Color fundus photograph — 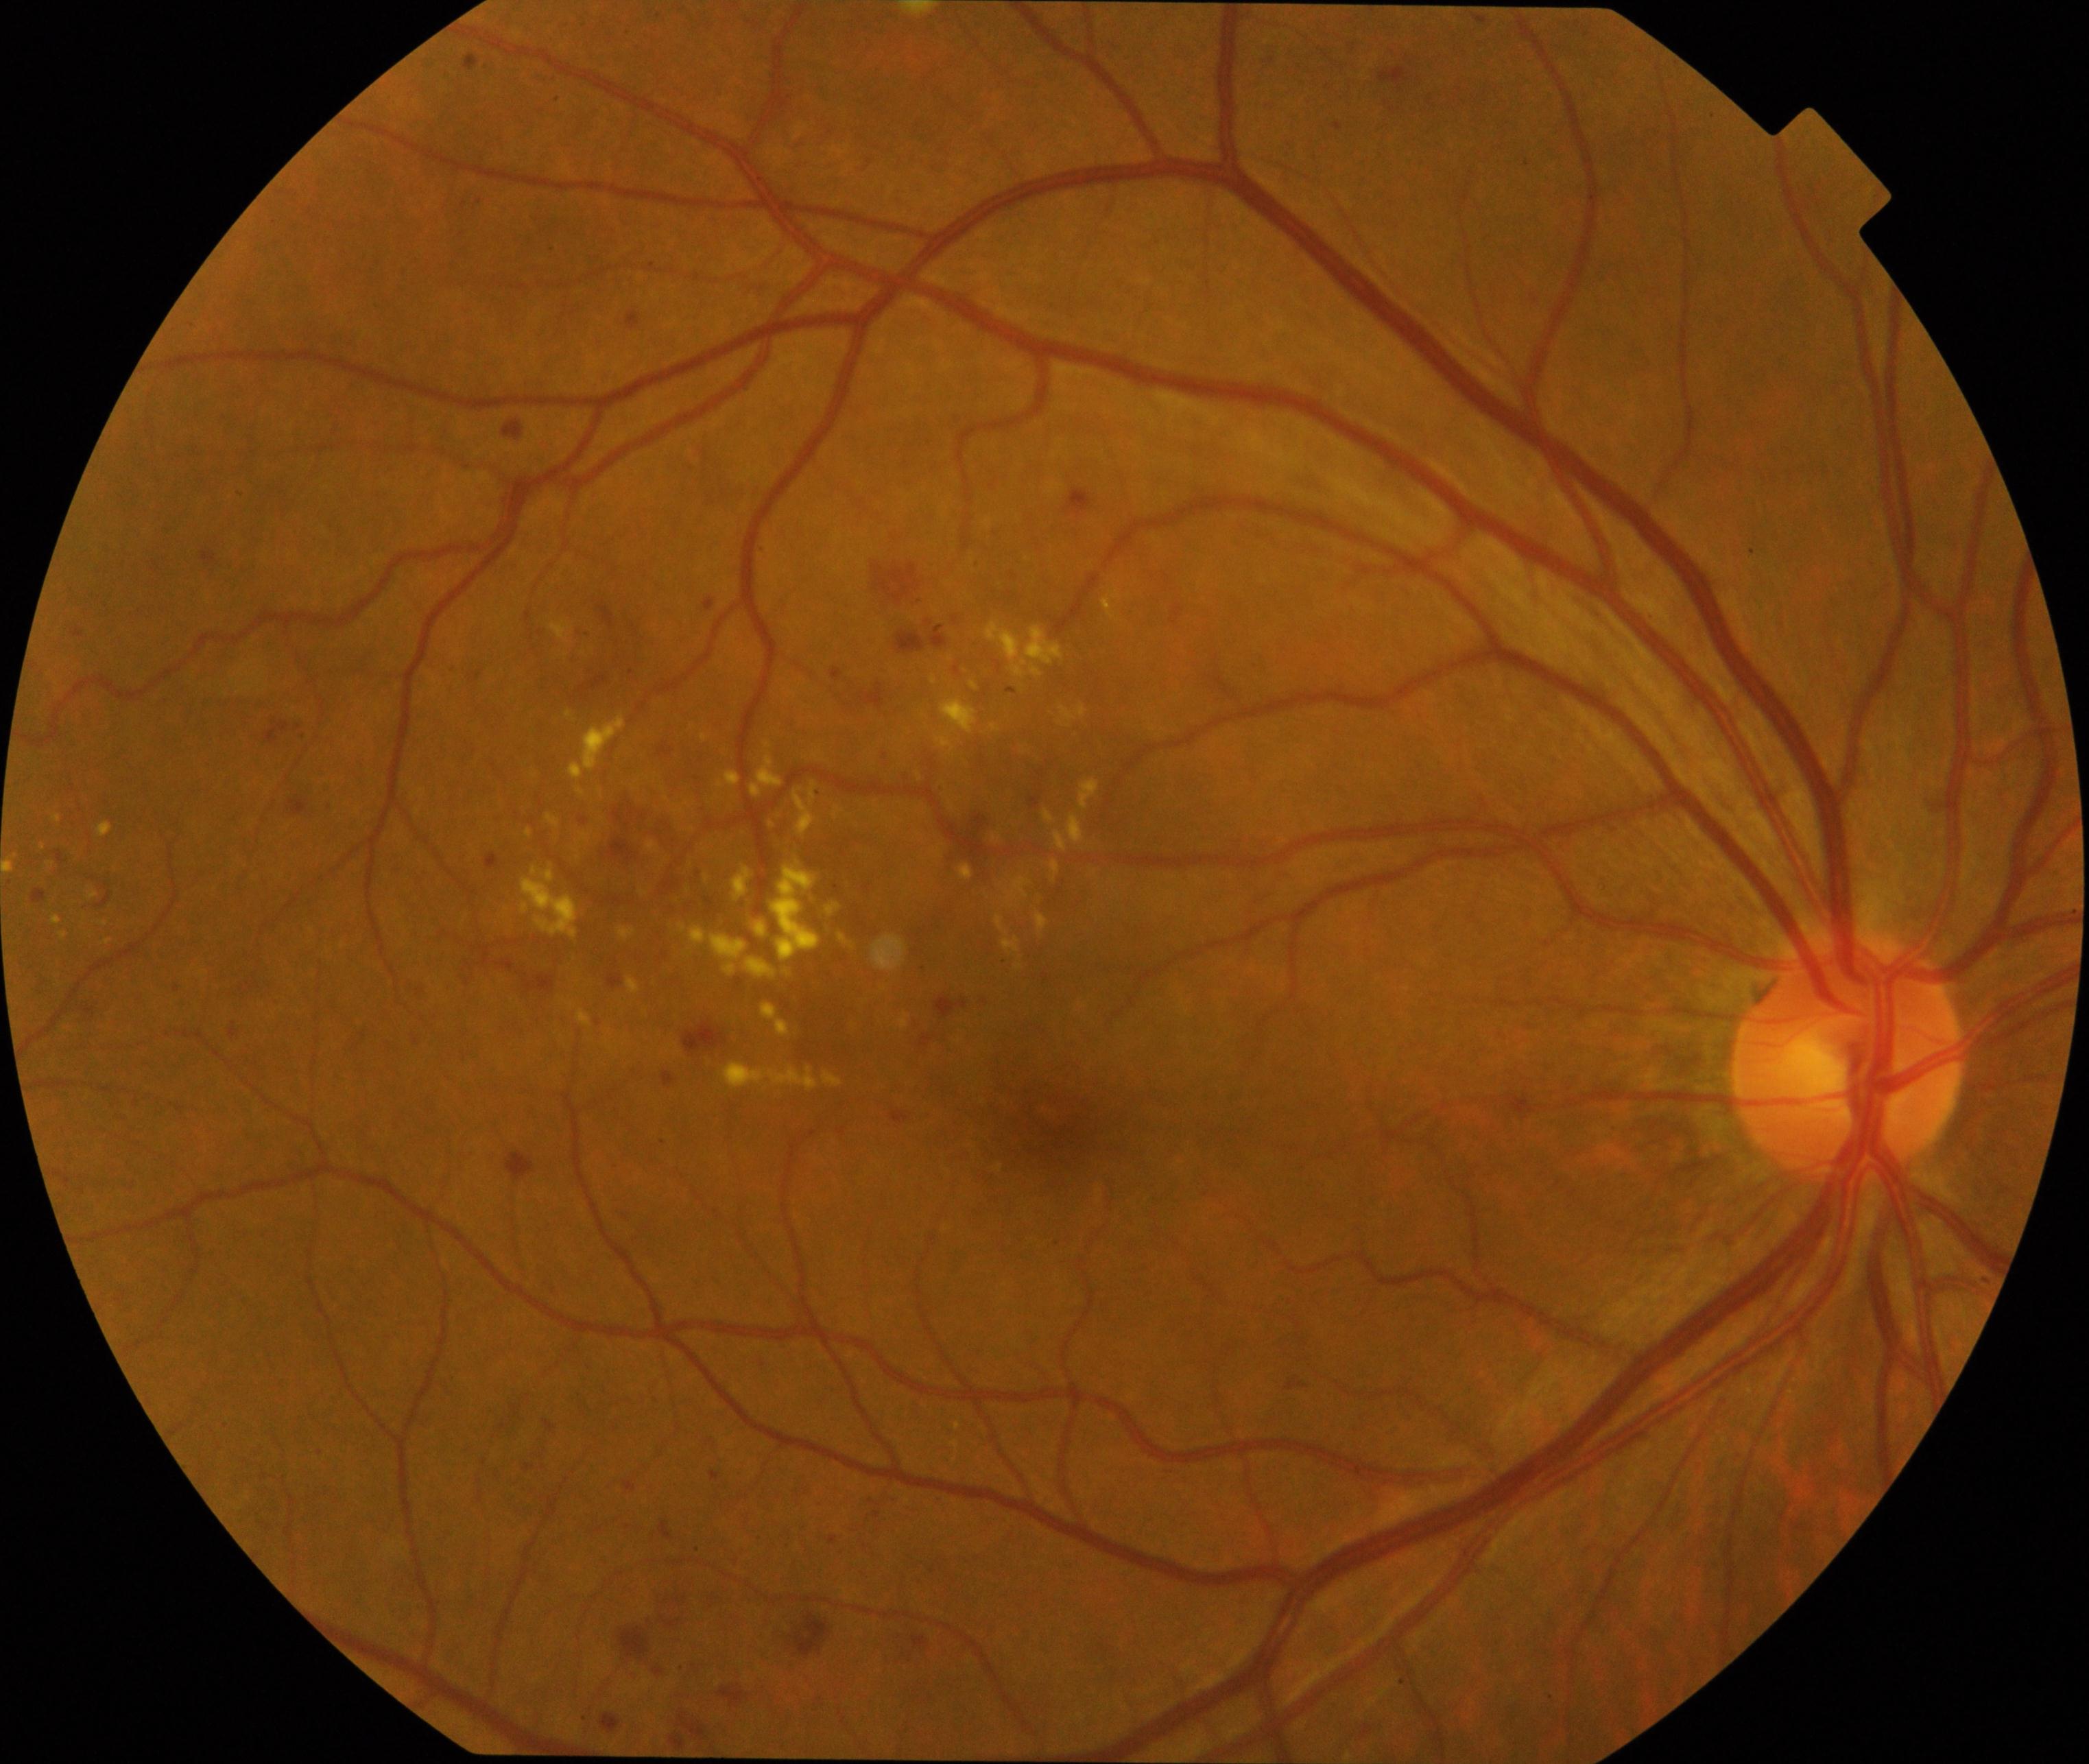
Findings: moderate non-proliferative diabetic retinopathy.